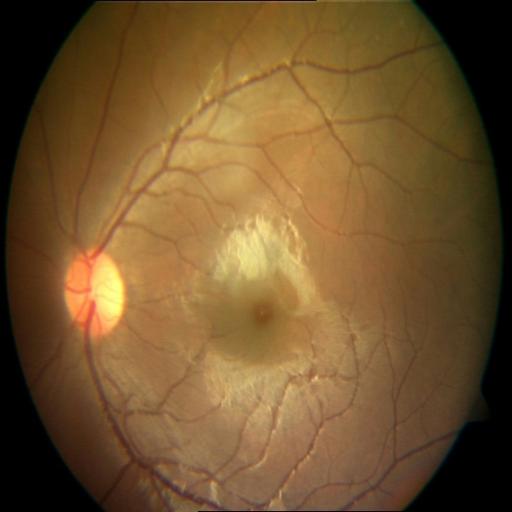 Pathology:
- CSR (central serous retinopathy)